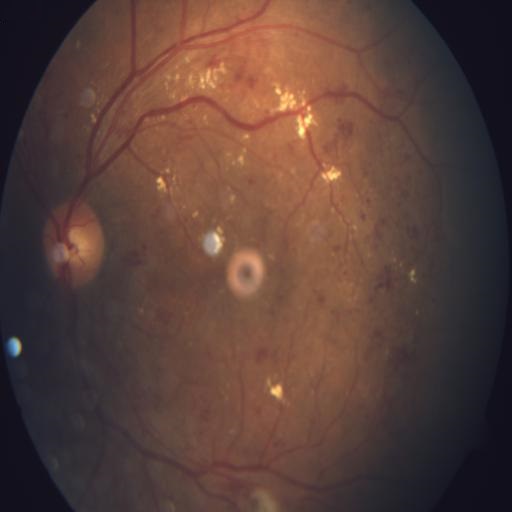 Four abnormalities. Findings consistent with cotton wool spots (CWS), exudation (EDN), hemorrhagic retinopathy (HR) & macular edema (ME).